DR severity per modified Davis staging.
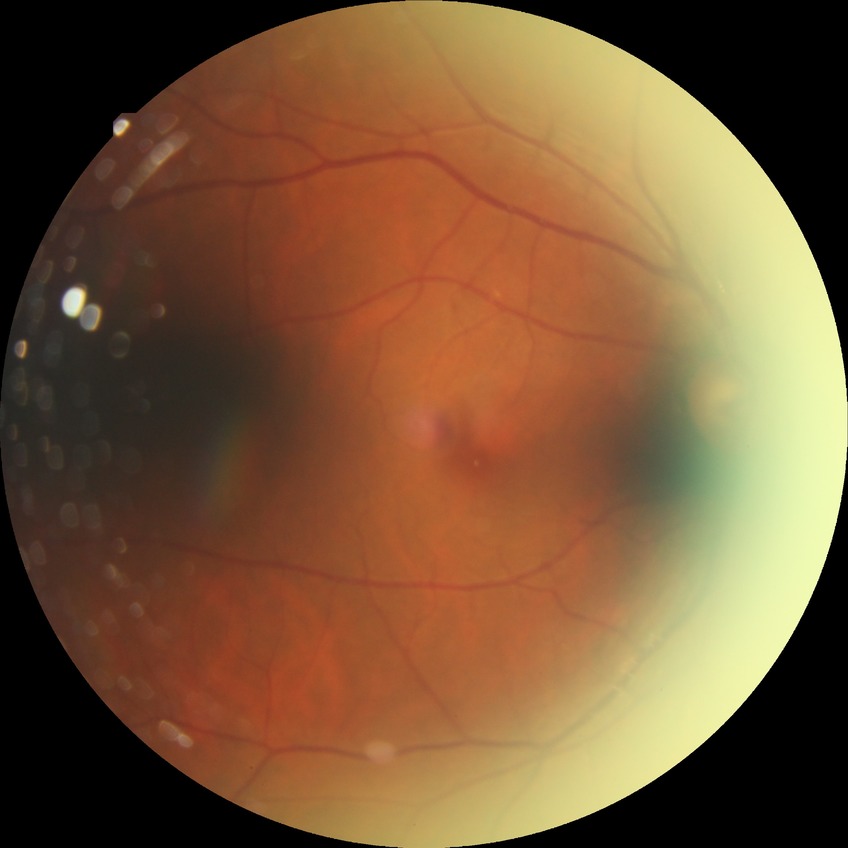

diabetic retinopathy (DR): NDR (no diabetic retinopathy).